45° field of view:
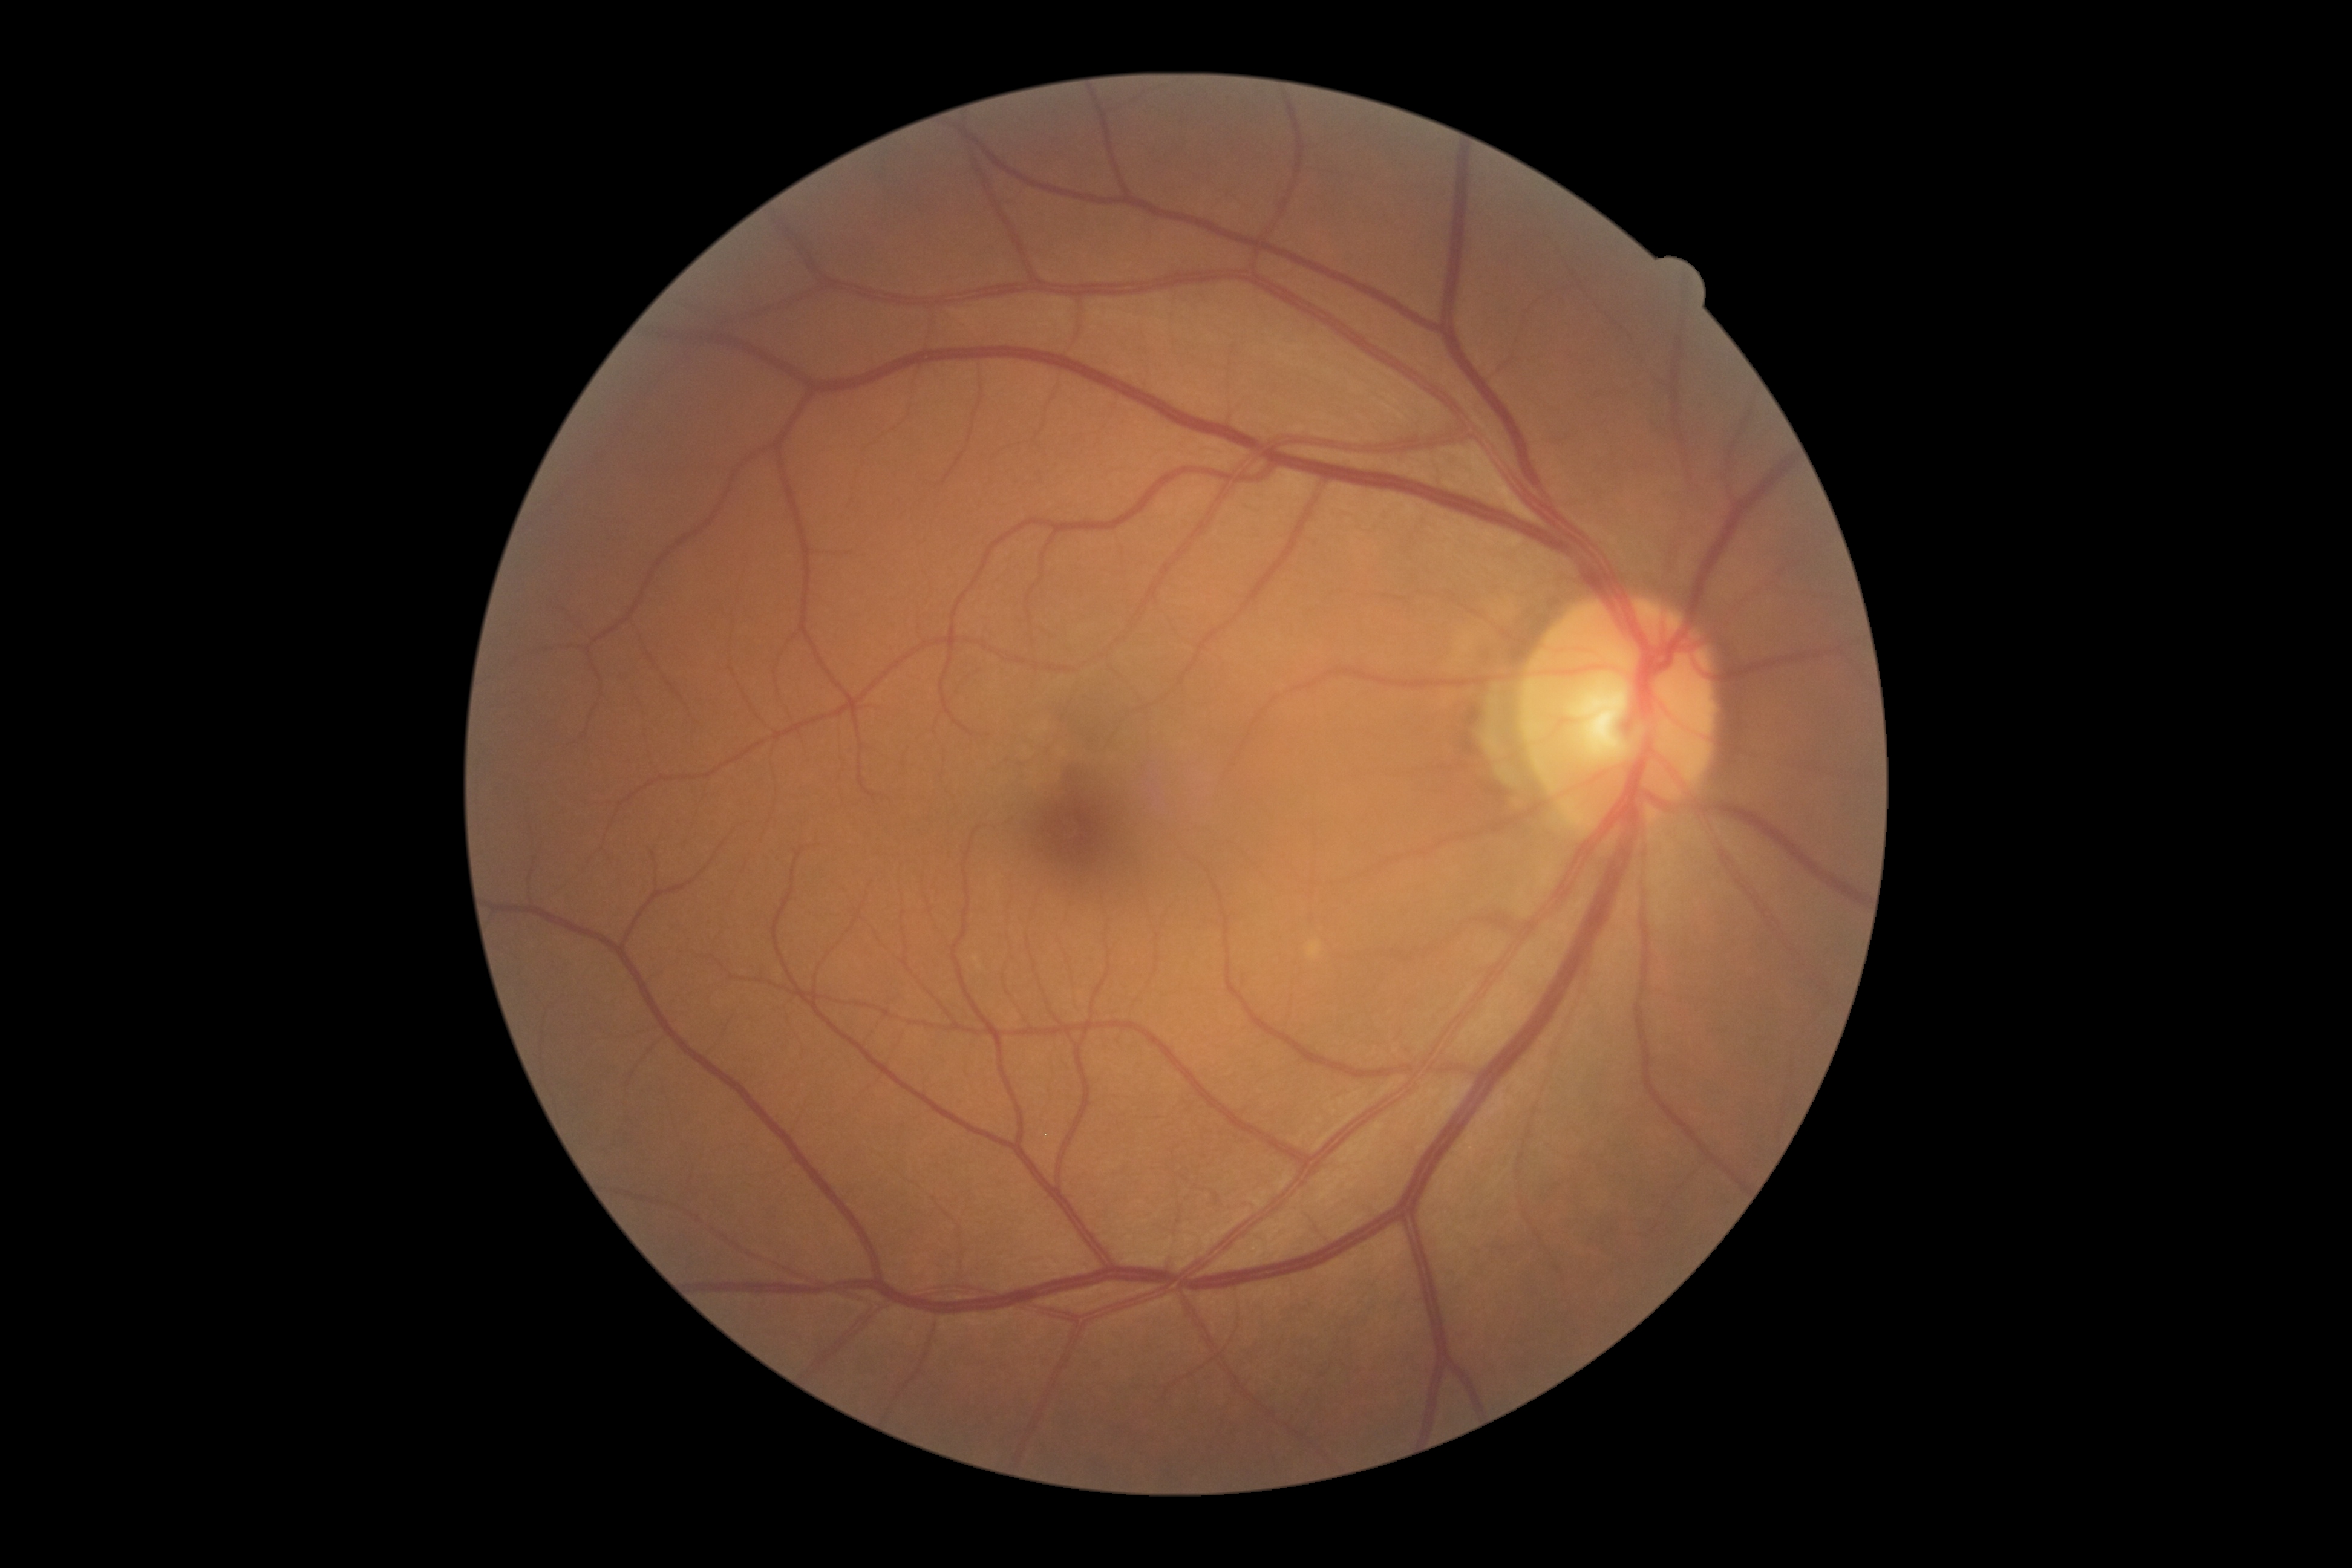

Diabetic retinopathy grade is no apparent retinopathy (0). No diabetic retinal disease findings.